Axial length: 23.53 mm. IOP 12 mmHg. Corneal thickness: 452 µm. Sex: male. Patient age: 55 years: 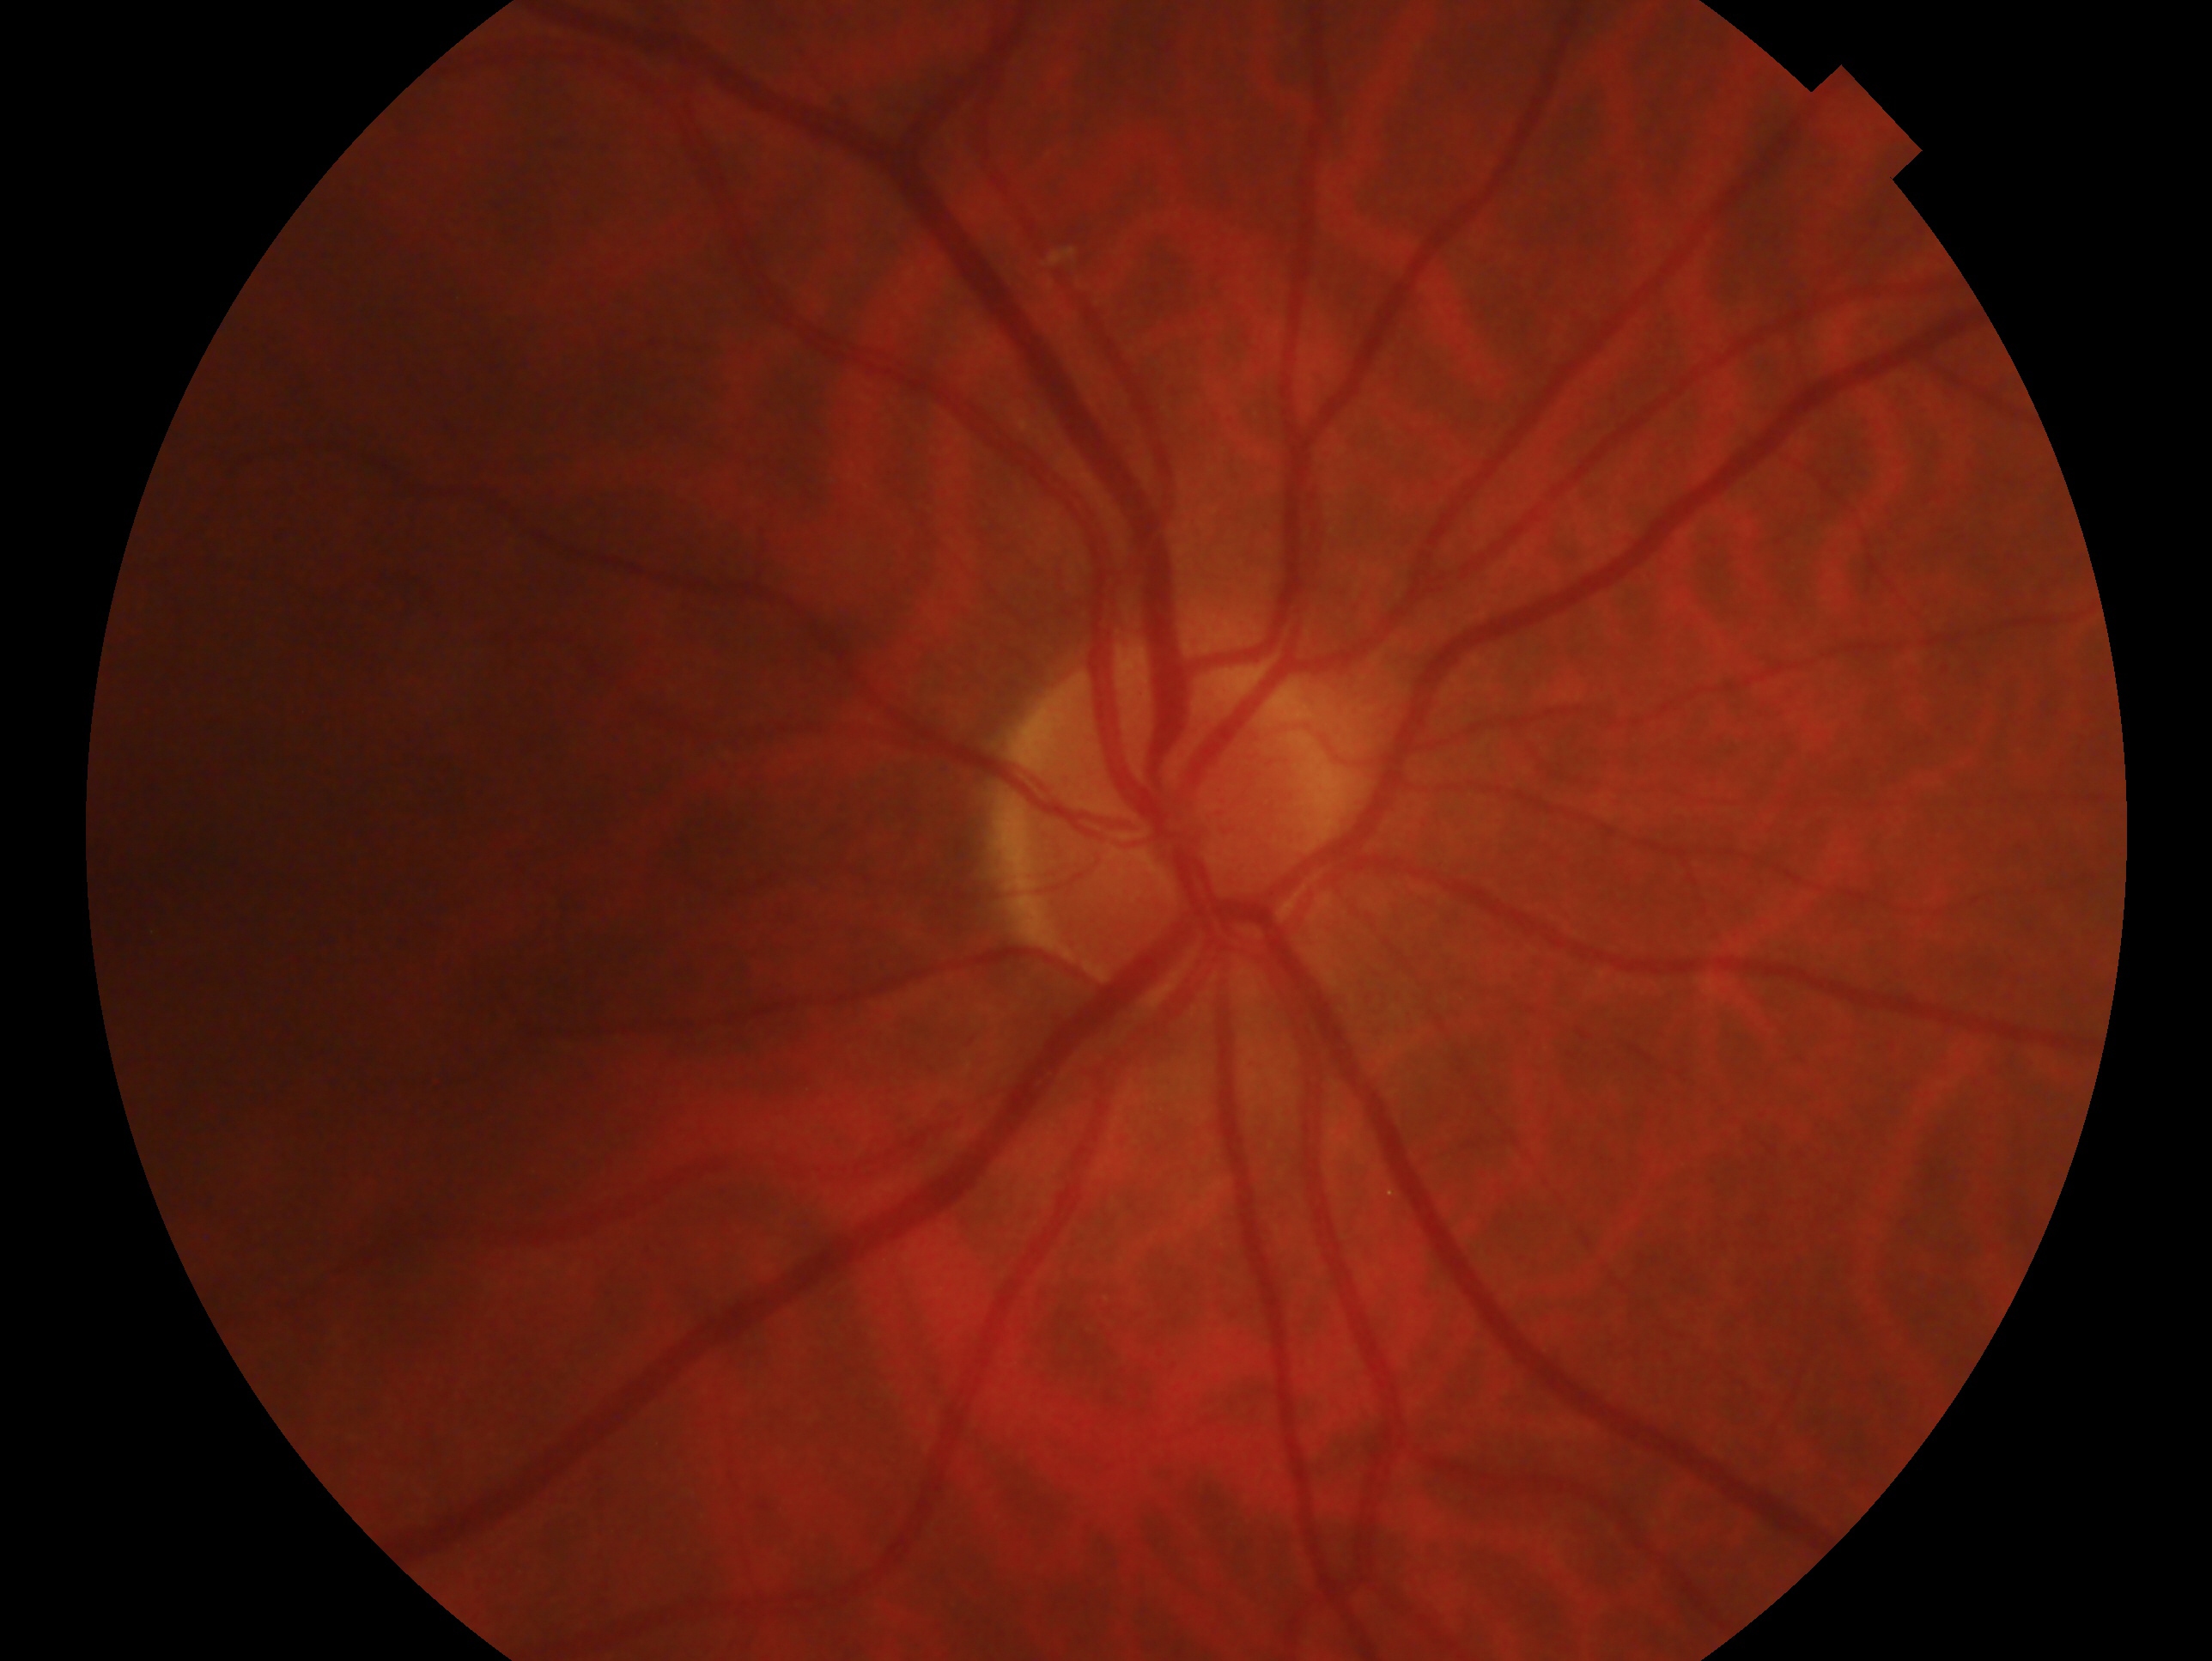

  eye: right
  glaucoma_dx: negative for glaucoma